FOV: 45 degrees. Acquired with a NIDEK AFC-230. Nonmydriatic. Davis DR grading: 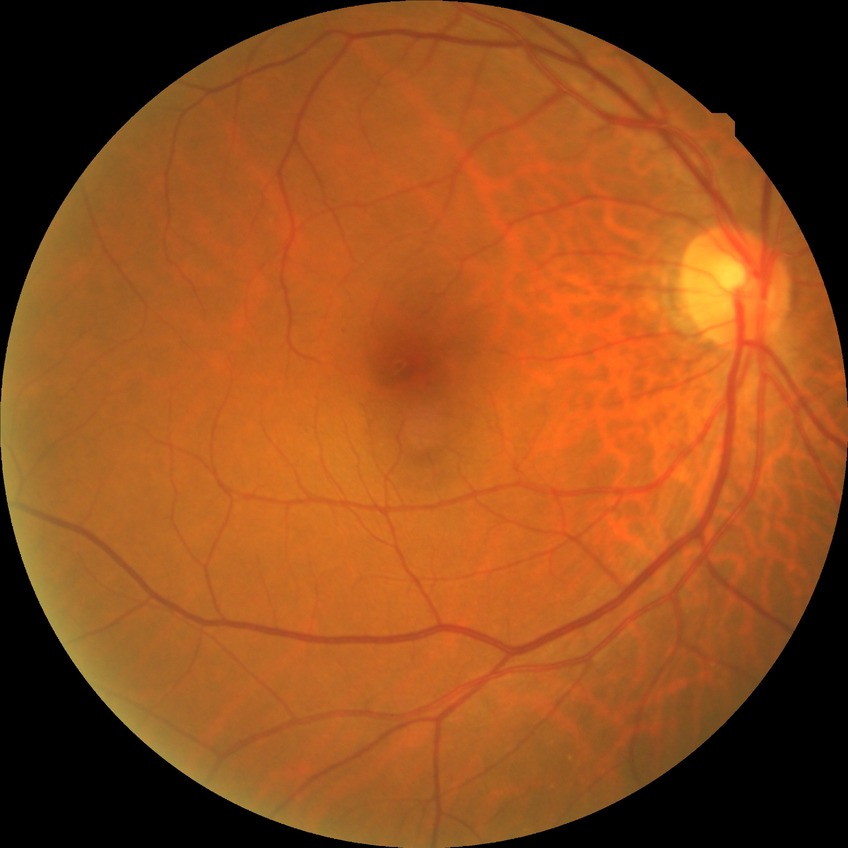

Diabetic retinopathy (DR) is no diabetic retinopathy (NDR).